Graded on the modified Davis scale:
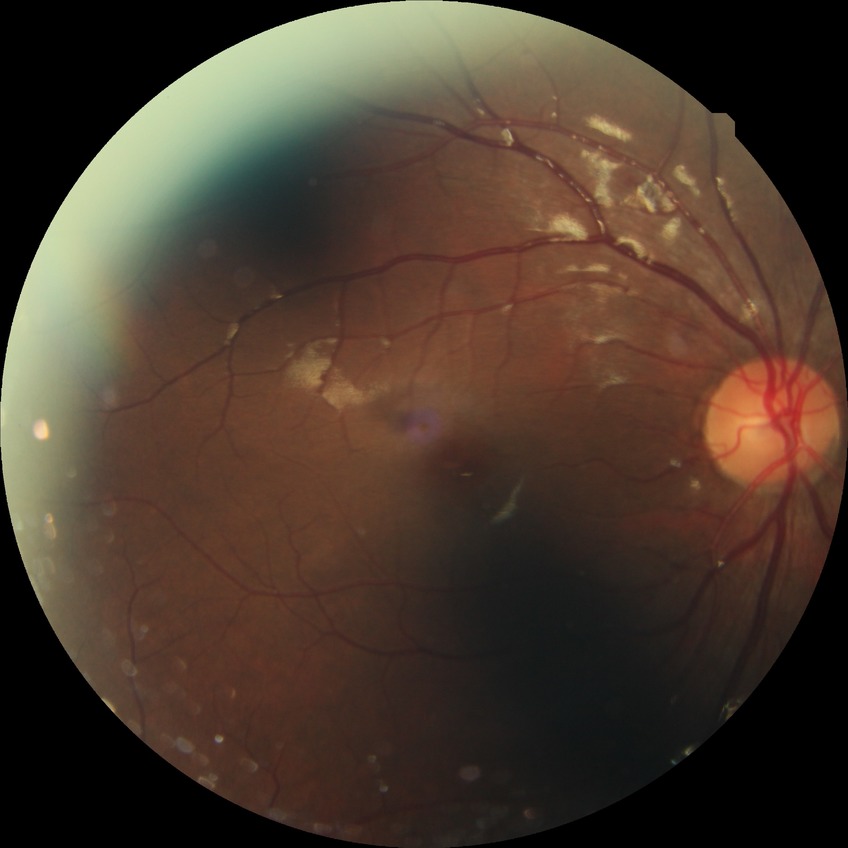
Diabetic retinopathy (DR): NDR (no diabetic retinopathy).